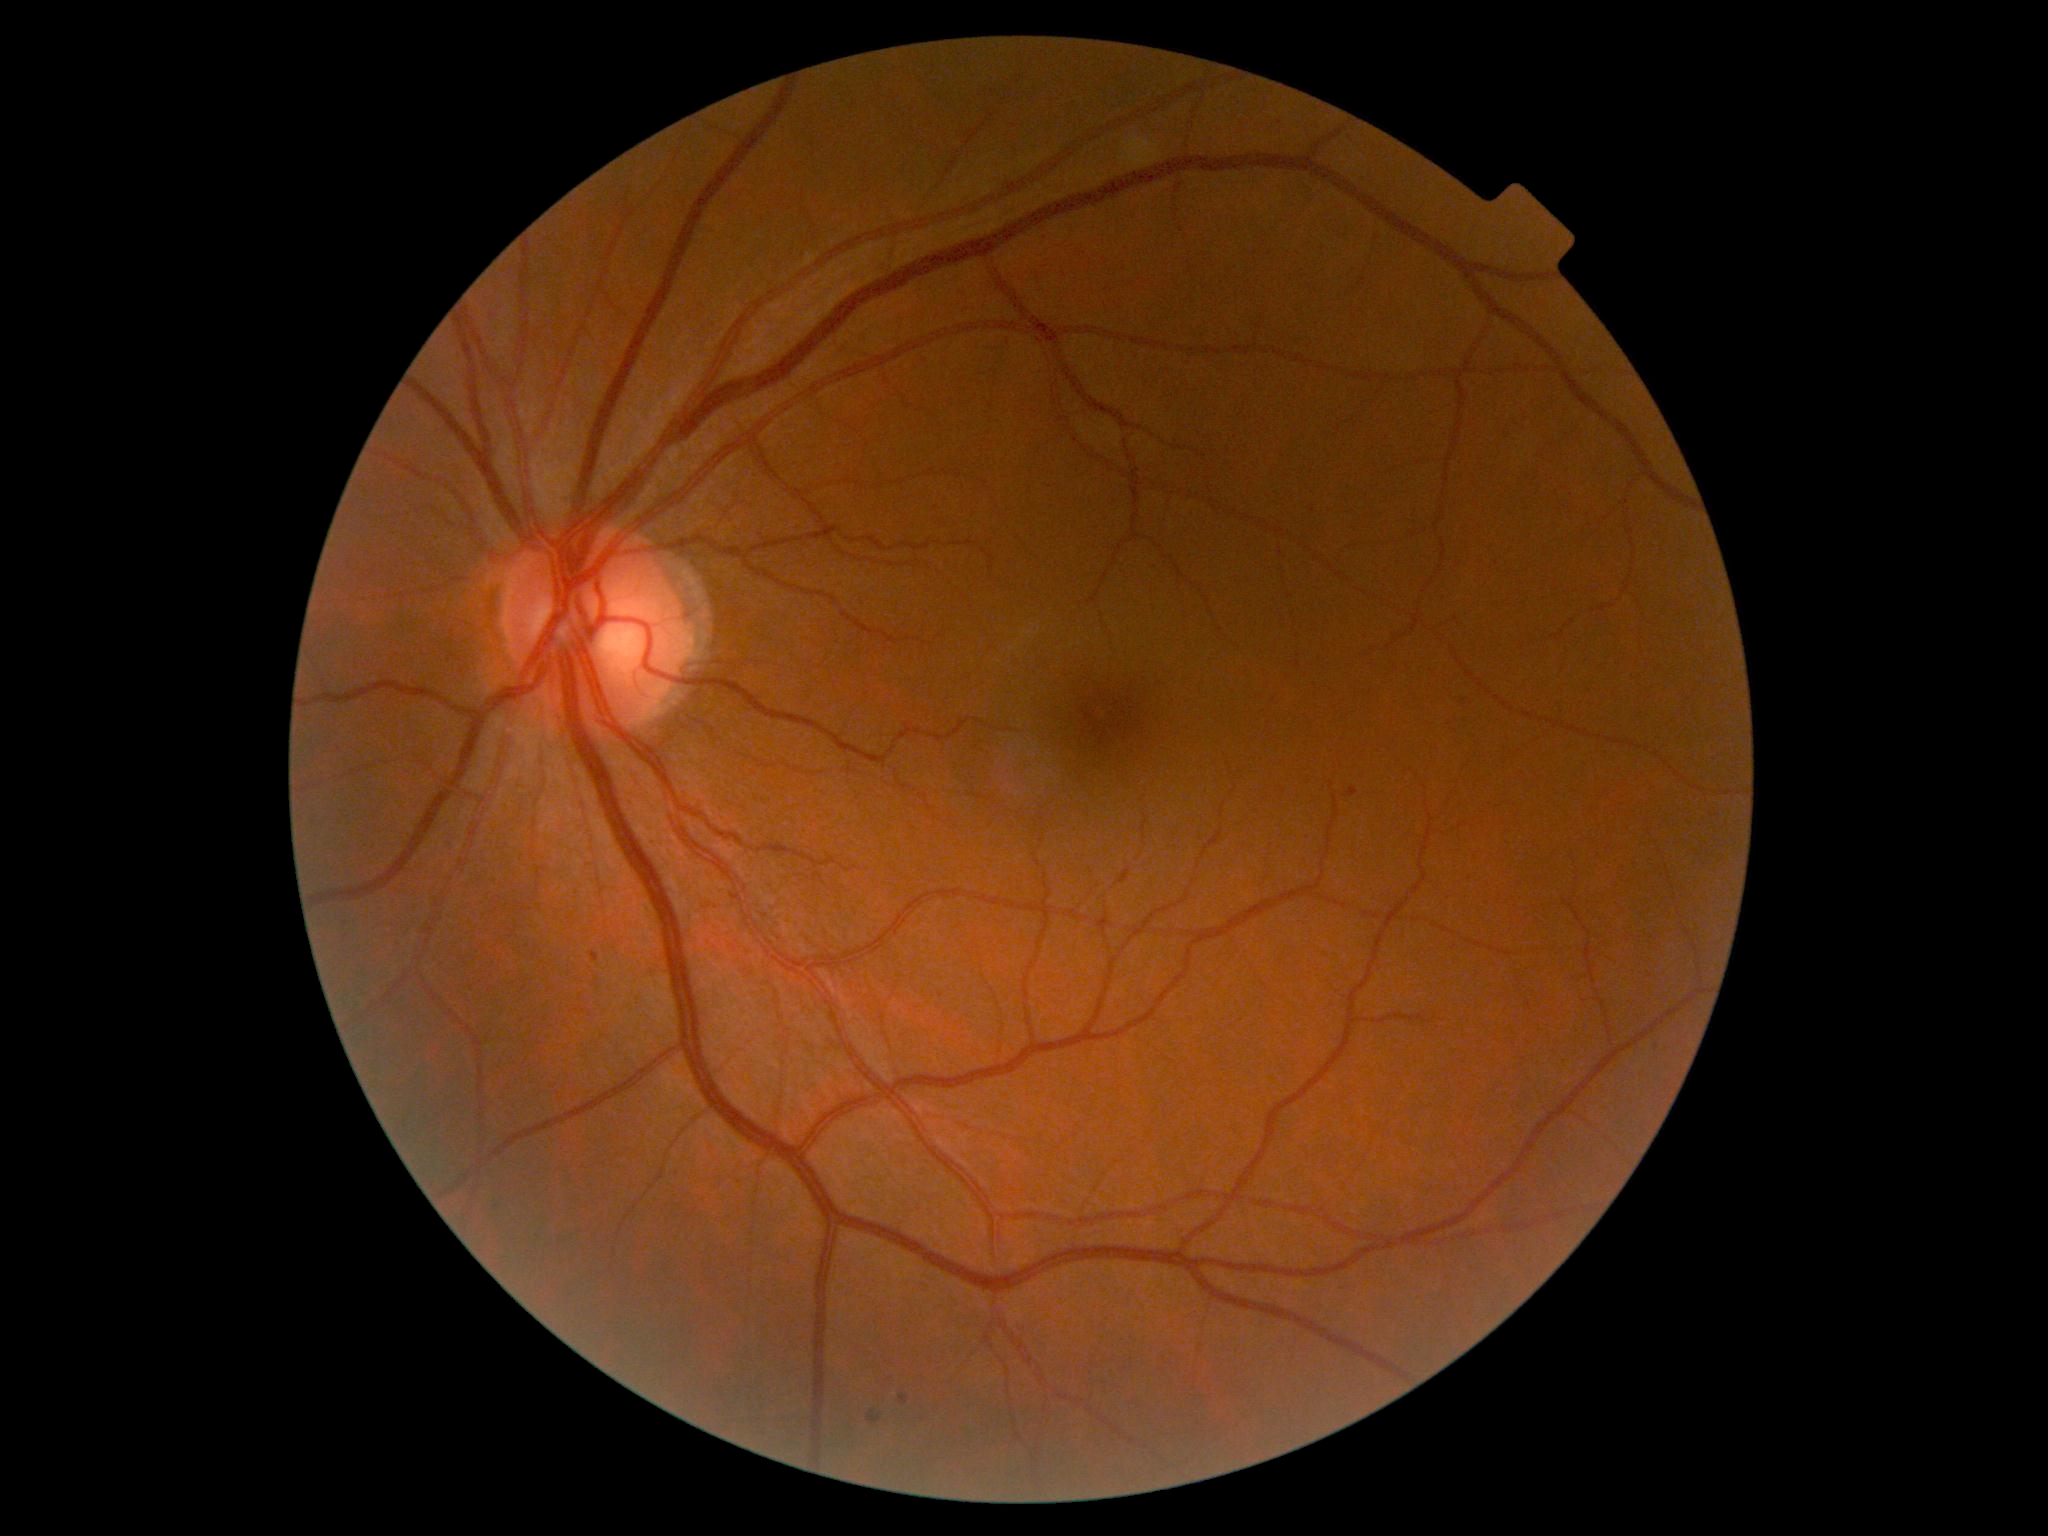

Diabetic retinopathy grade is 1.
Microaneurysms (partial list) at (left=590, top=952, right=600, bottom=962), (left=1345, top=787, right=1359, bottom=797), (left=868, top=1411, right=882, bottom=1423), (left=899, top=1396, right=909, bottom=1404).
No hemorrhages identified.
No hard exudates identified.
No soft exudates identified.